Fundus photo. 45 degree fundus photograph. No pharmacologic dilation:
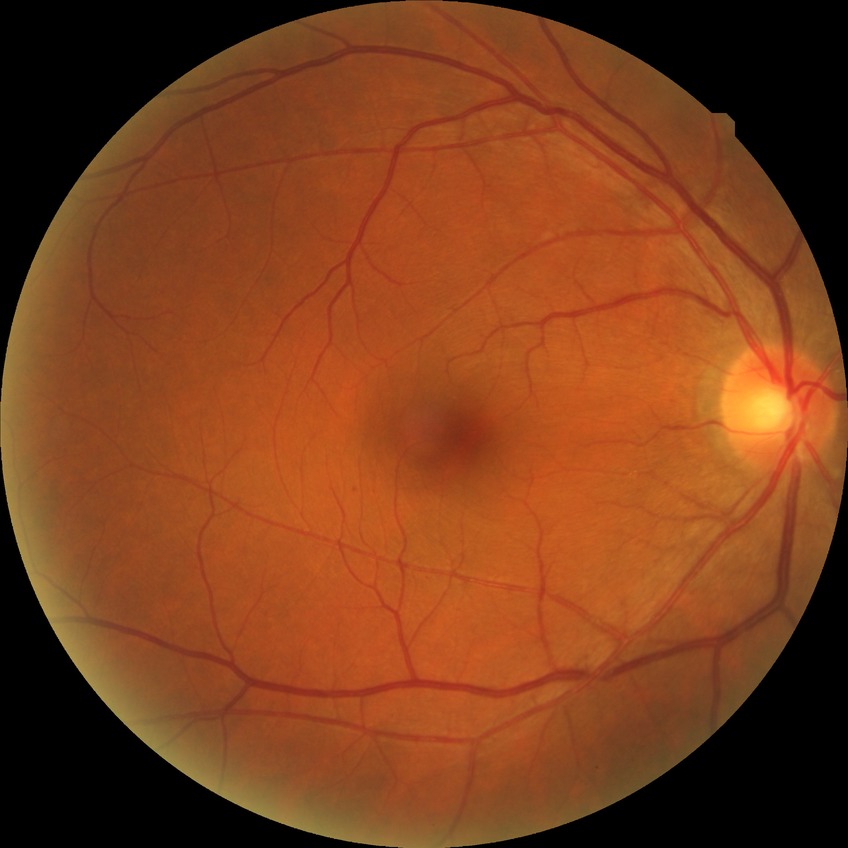

{
  "davis_grade": "no diabetic retinopathy"
}